2089 x 1764 pixels: 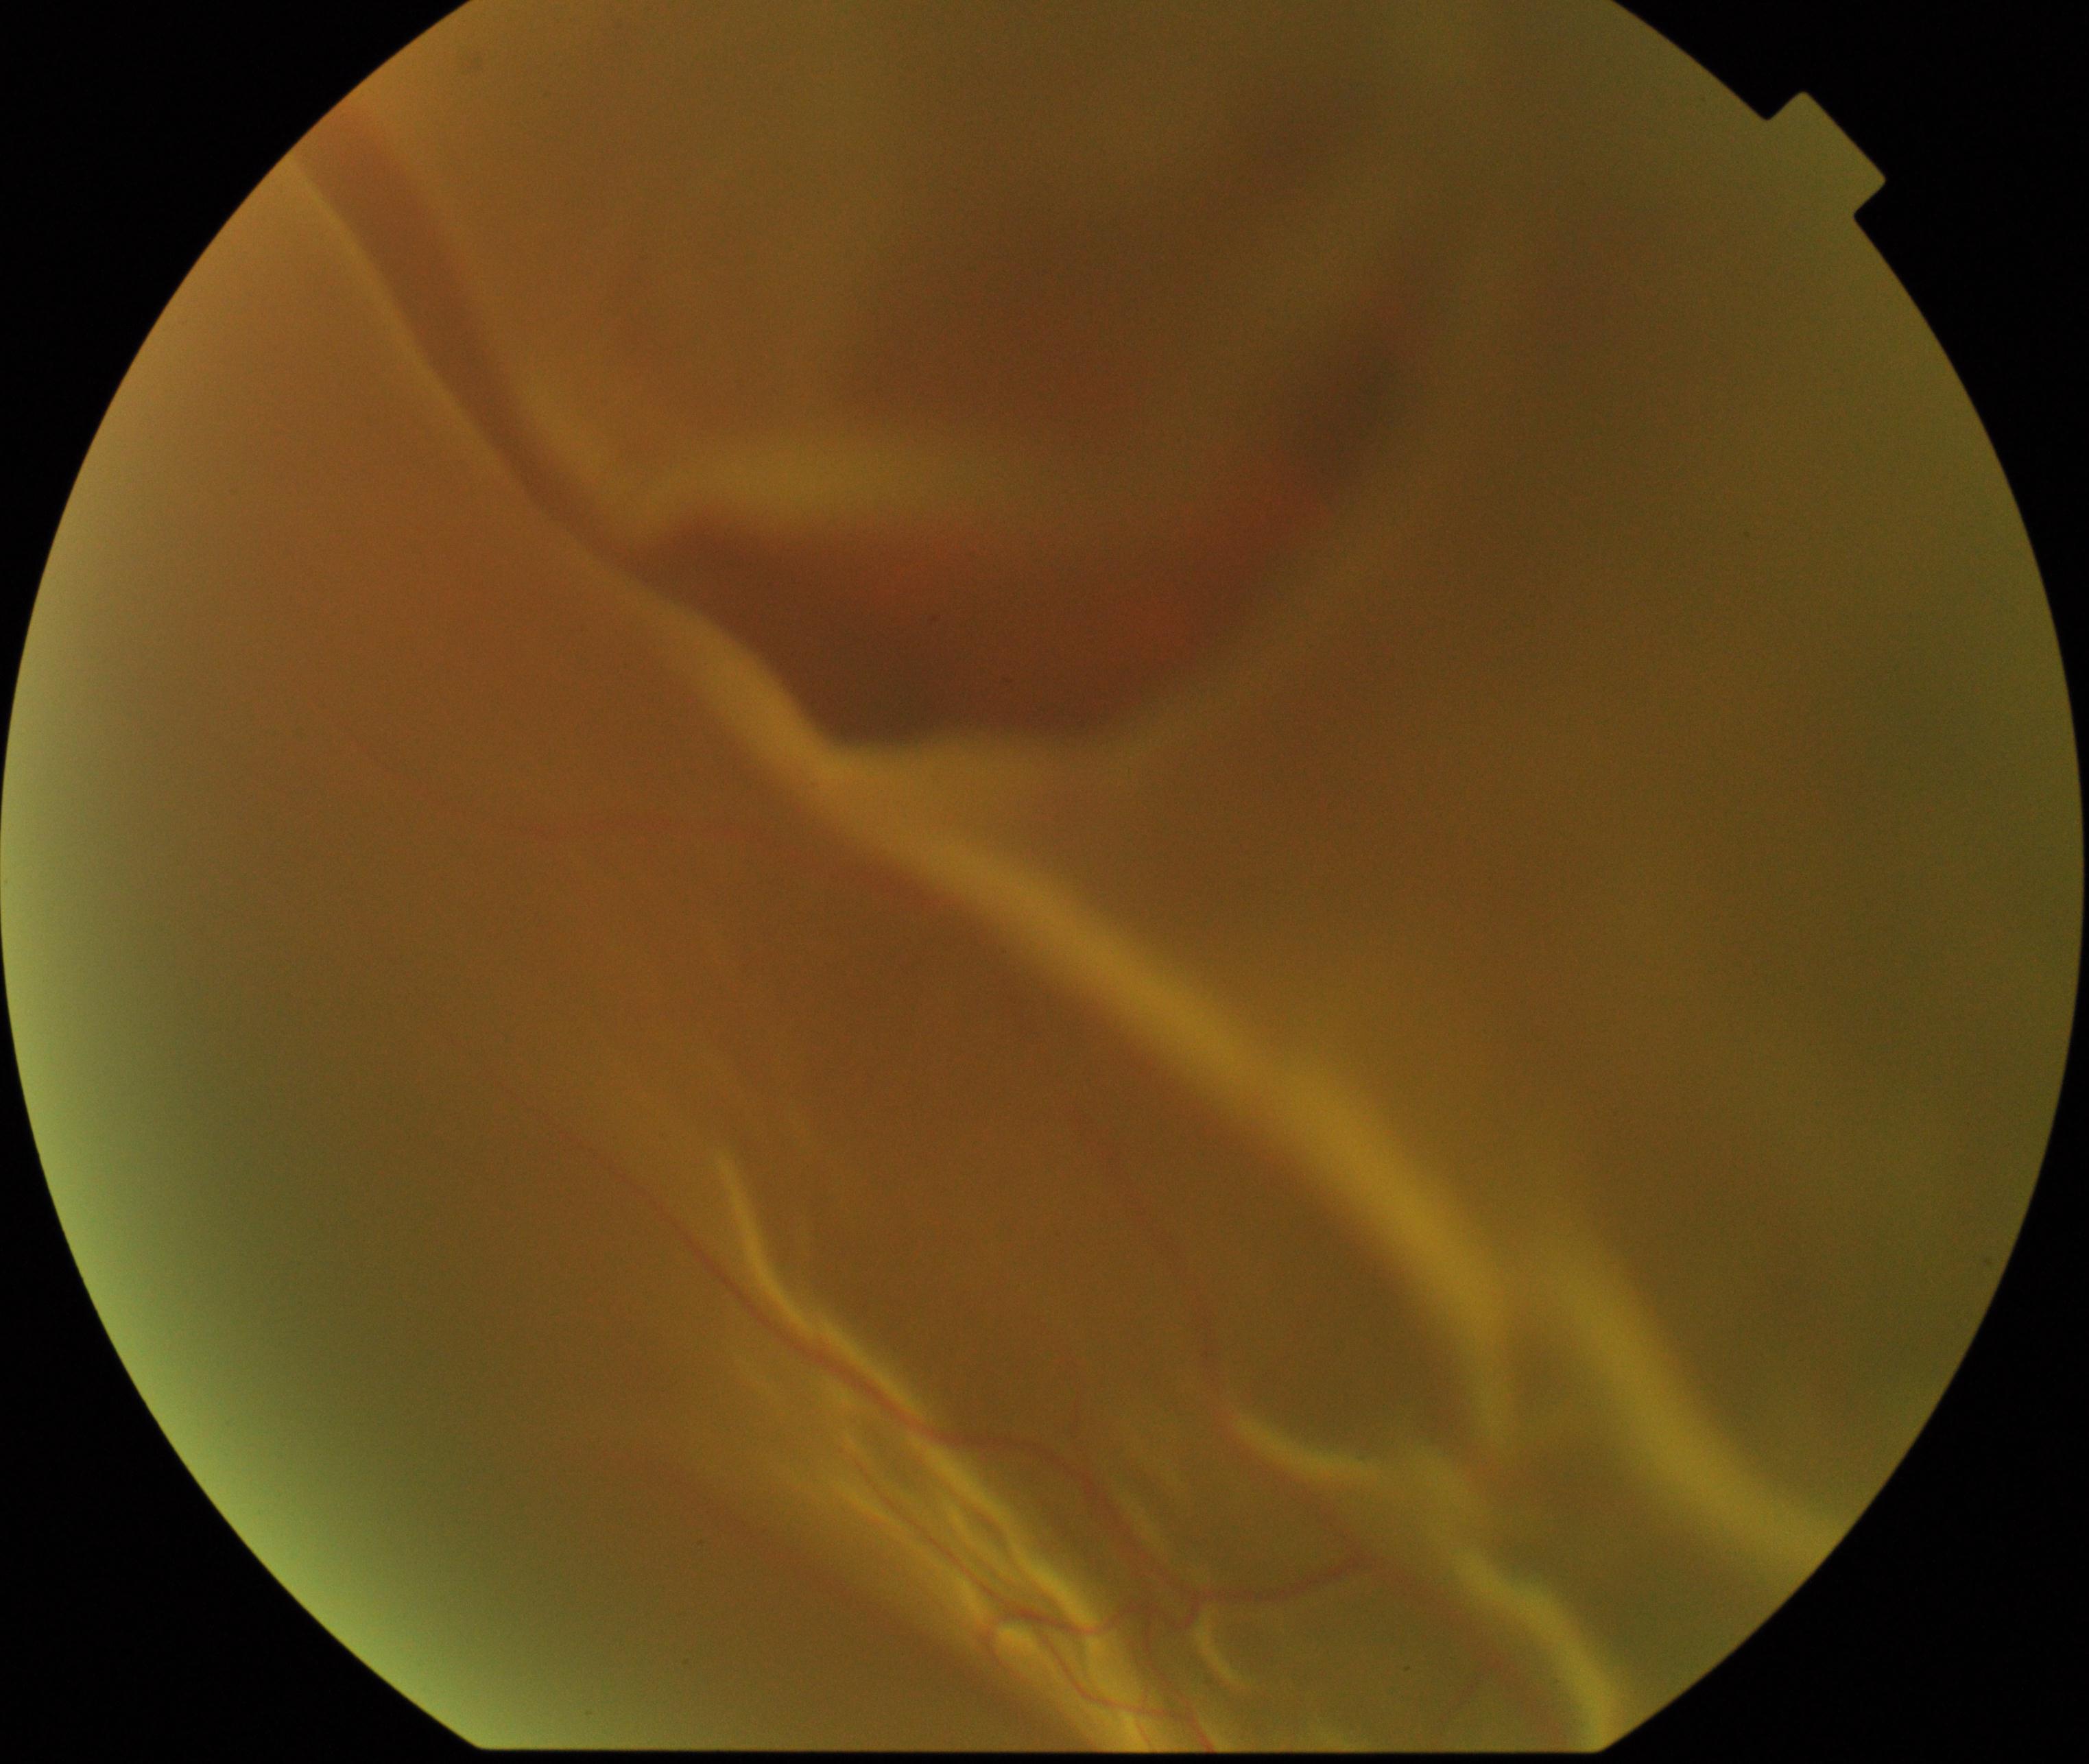
Classification: rhegmatogenous retinal detachment. Features include slightly opaque, convex or corrugated appearance of elevated retina, sometimes with retinal breaks in view.